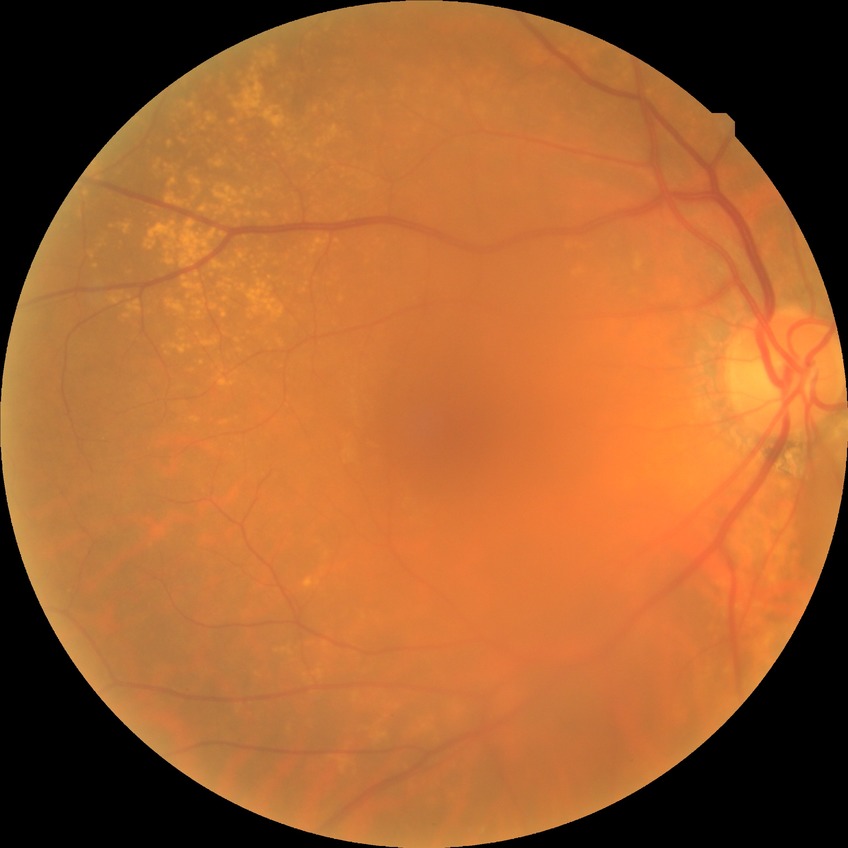

Diabetic retinopathy (DR): NDR (no diabetic retinopathy).